Acquired on the Natus RetCam Envision; wide-field fundus photograph from neonatal ROP screening; 1440 by 1080 pixels
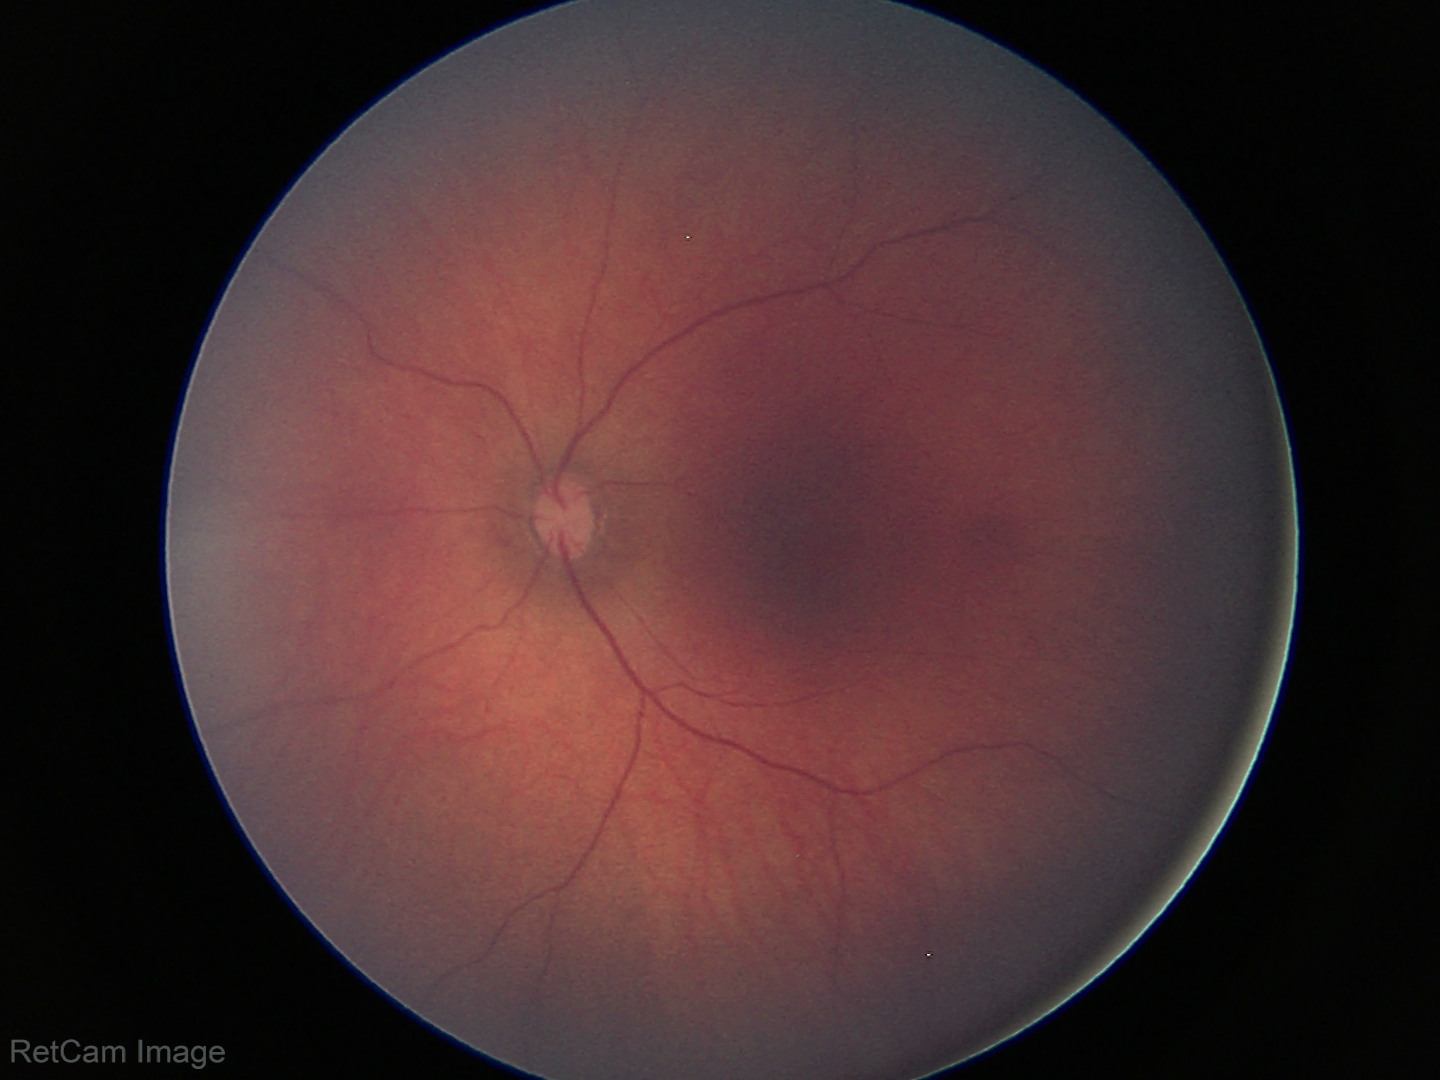 Examination with physiological retinal findings.